Wide-field fundus image from infant ROP screening · acquired on the Clarity RetCam 3.
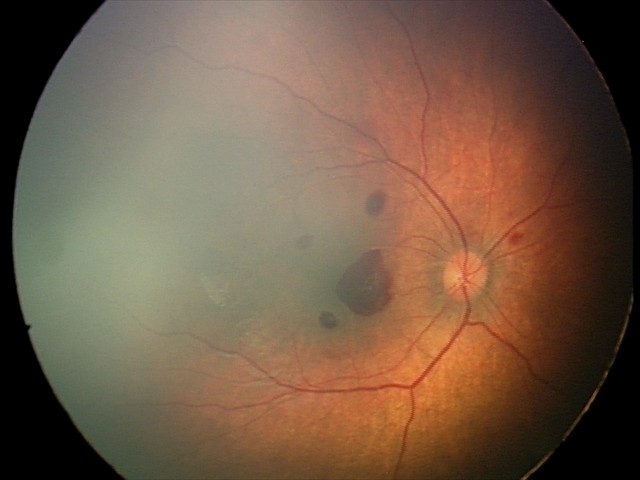
Q: What was the screening finding?
A: retinal hemorrhages